CFP — 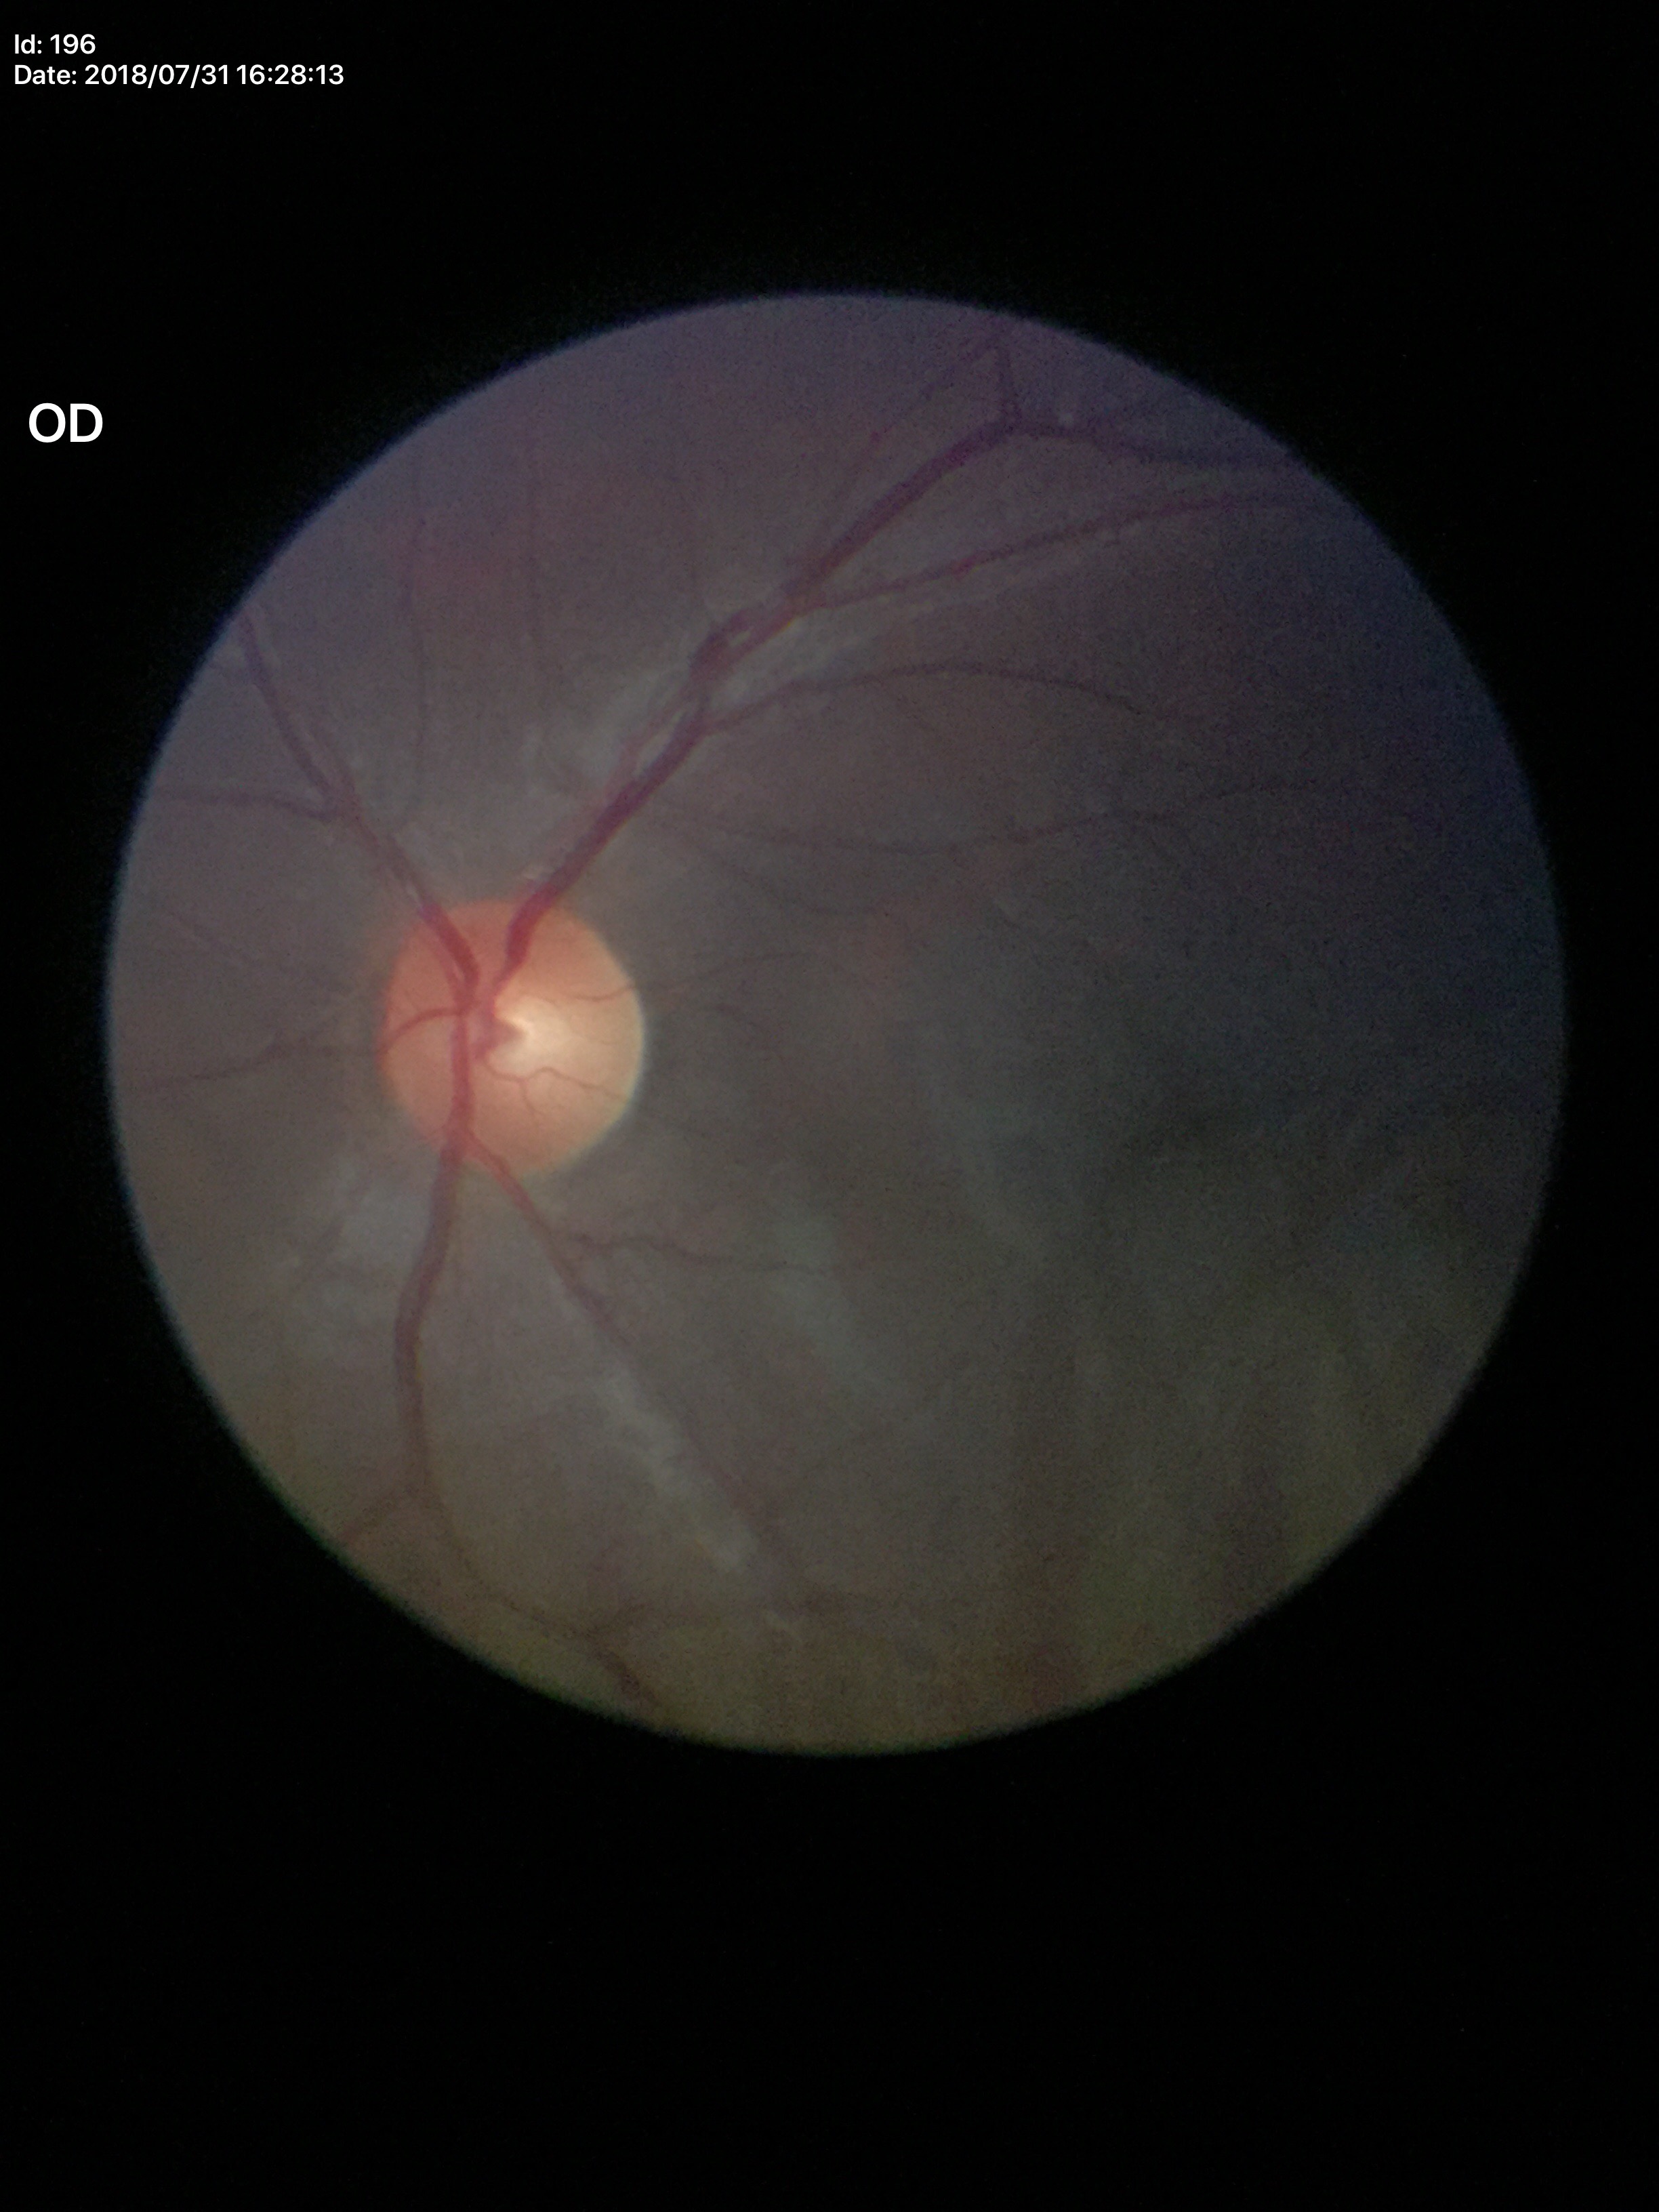

• Glaucoma impression: not suspect
• vertical C/D ratio: 0.47
• horizontal cup-disc ratio: 0.49